Captured with the Phoenix ICON (100° field of view); Phoenix ICON wide-field infant fundus image — 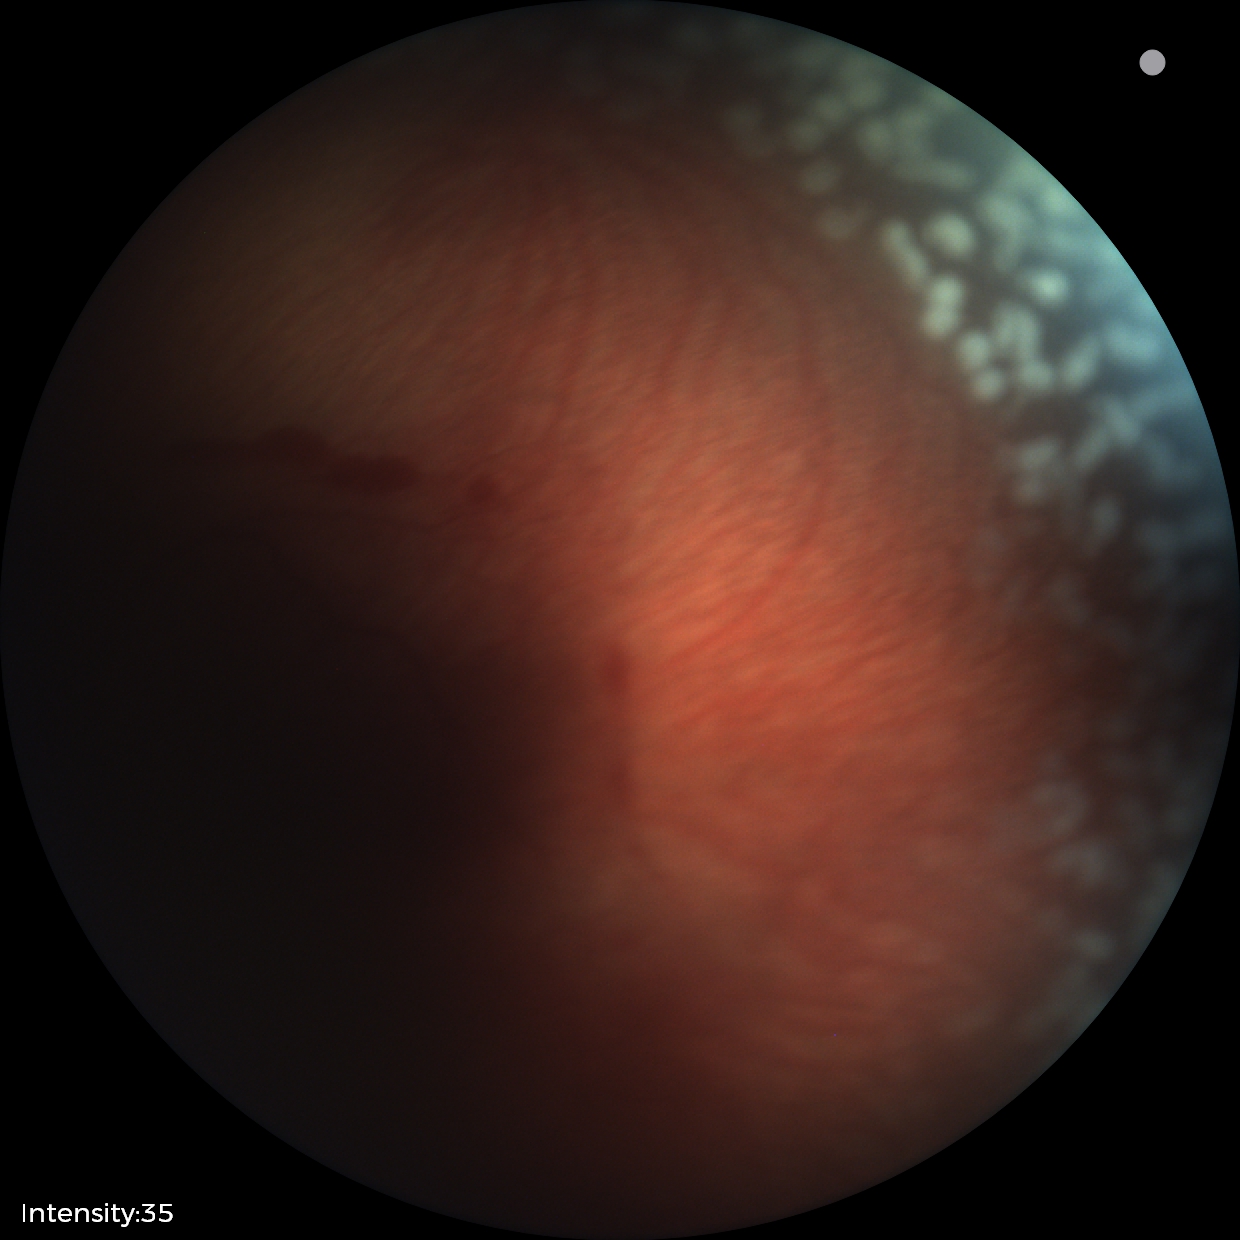

With plus disease. Series diagnosed as retinopathy of prematurity (ROP) stage 2.